NIDEK AFC-230 fundus camera; posterior pole photograph; FOV: 45 degrees; without pupil dilation — 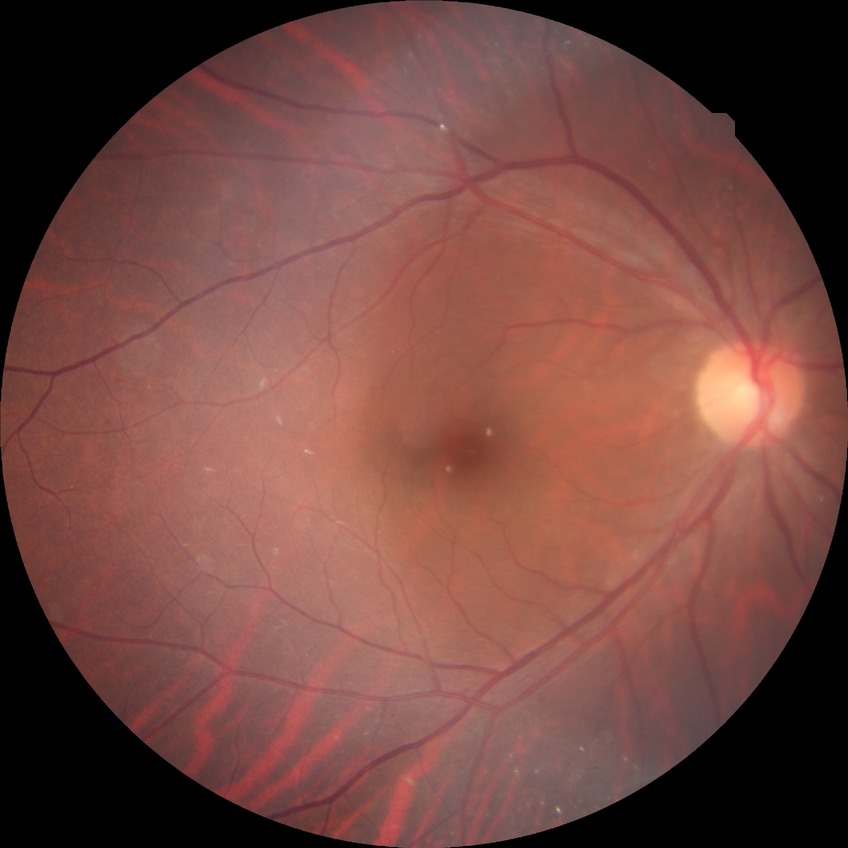   davis_grade: no diabetic retinopathy (NDR)